Infant wide-field fundus photograph · Natus RetCam Envision, 130° FOV · 1440 x 1080 pixels:
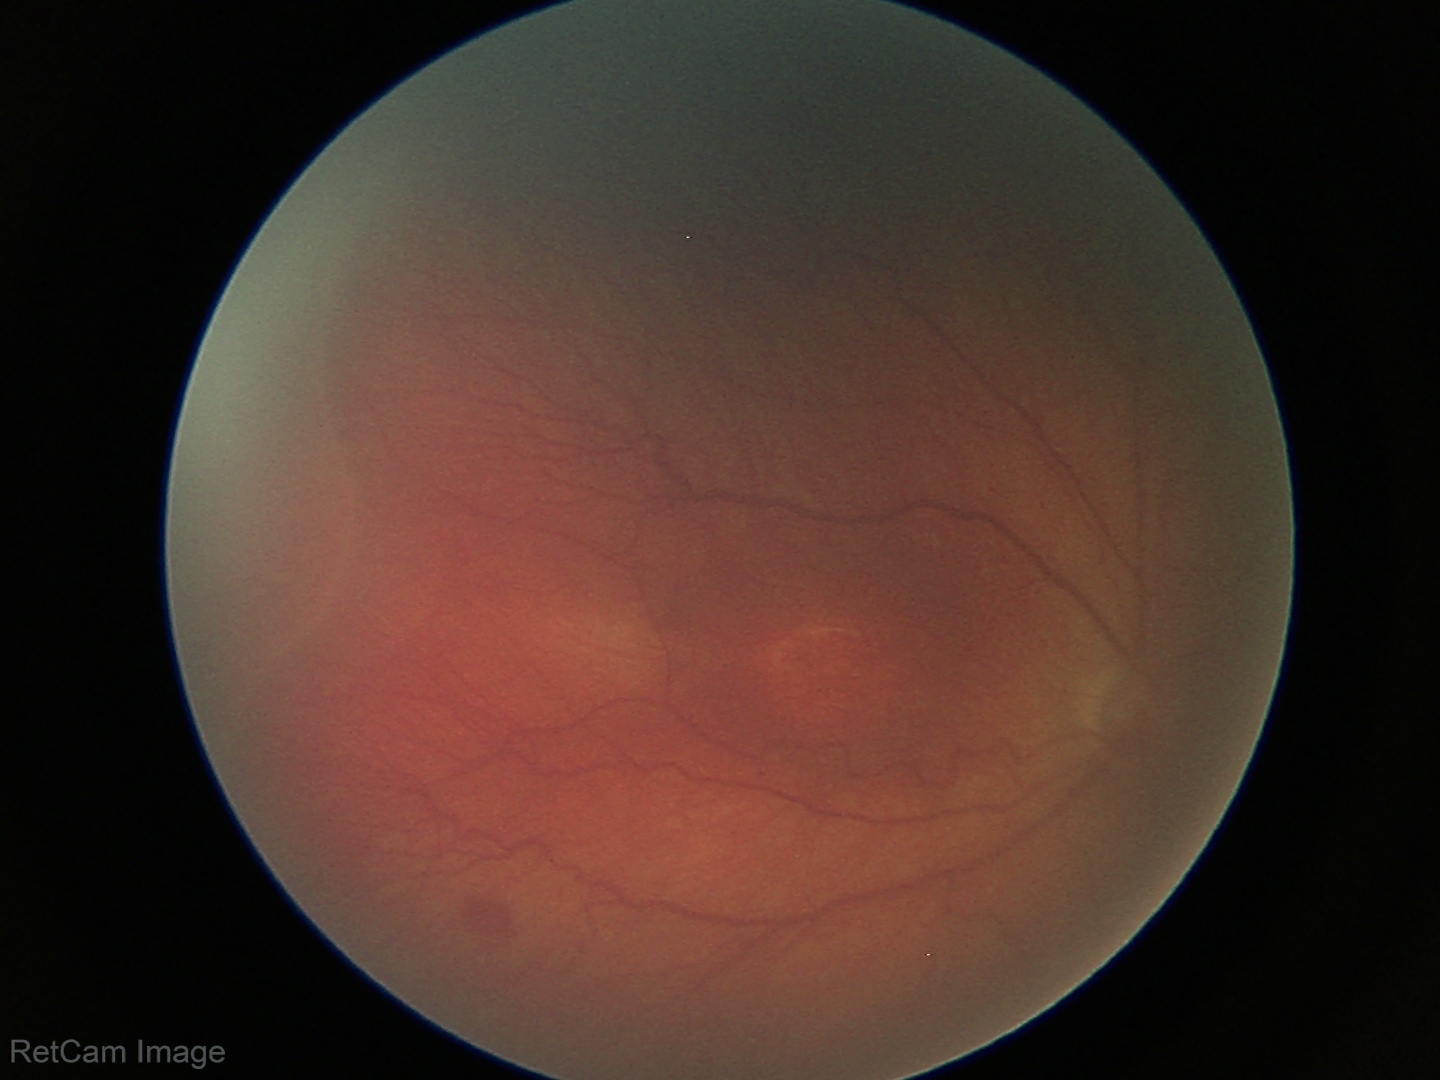

Screening series with retinopathy of prematurity stage 3. Without plus disease.